Graded on the modified Davis scale:
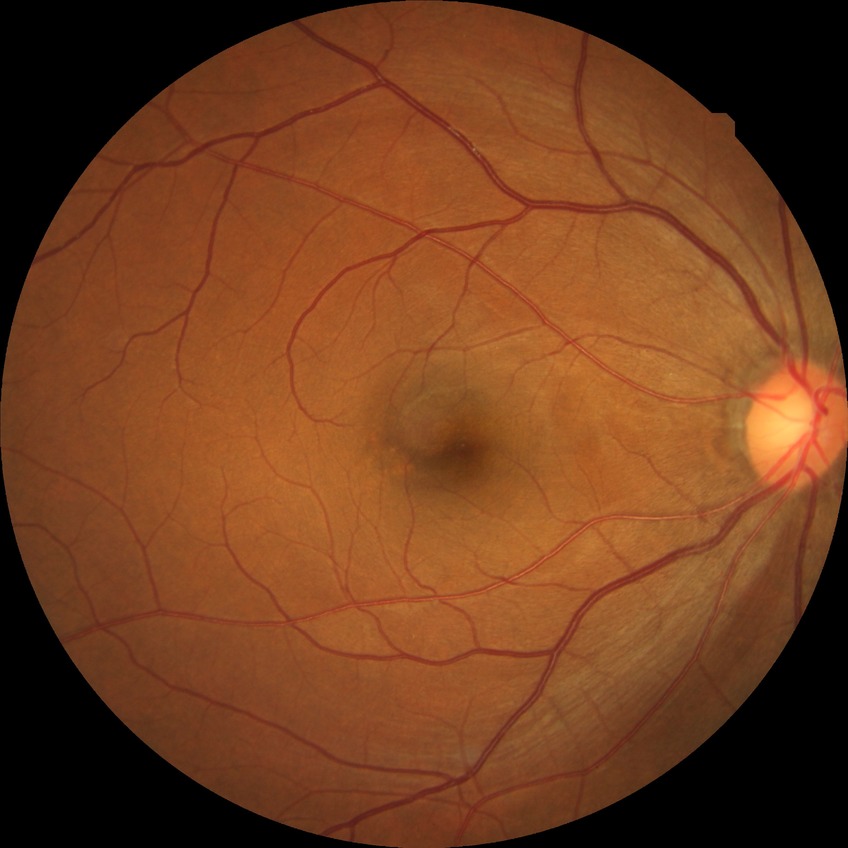
Diabetic retinopathy (DR) is NDR (no diabetic retinopathy).